45-degree field of view — 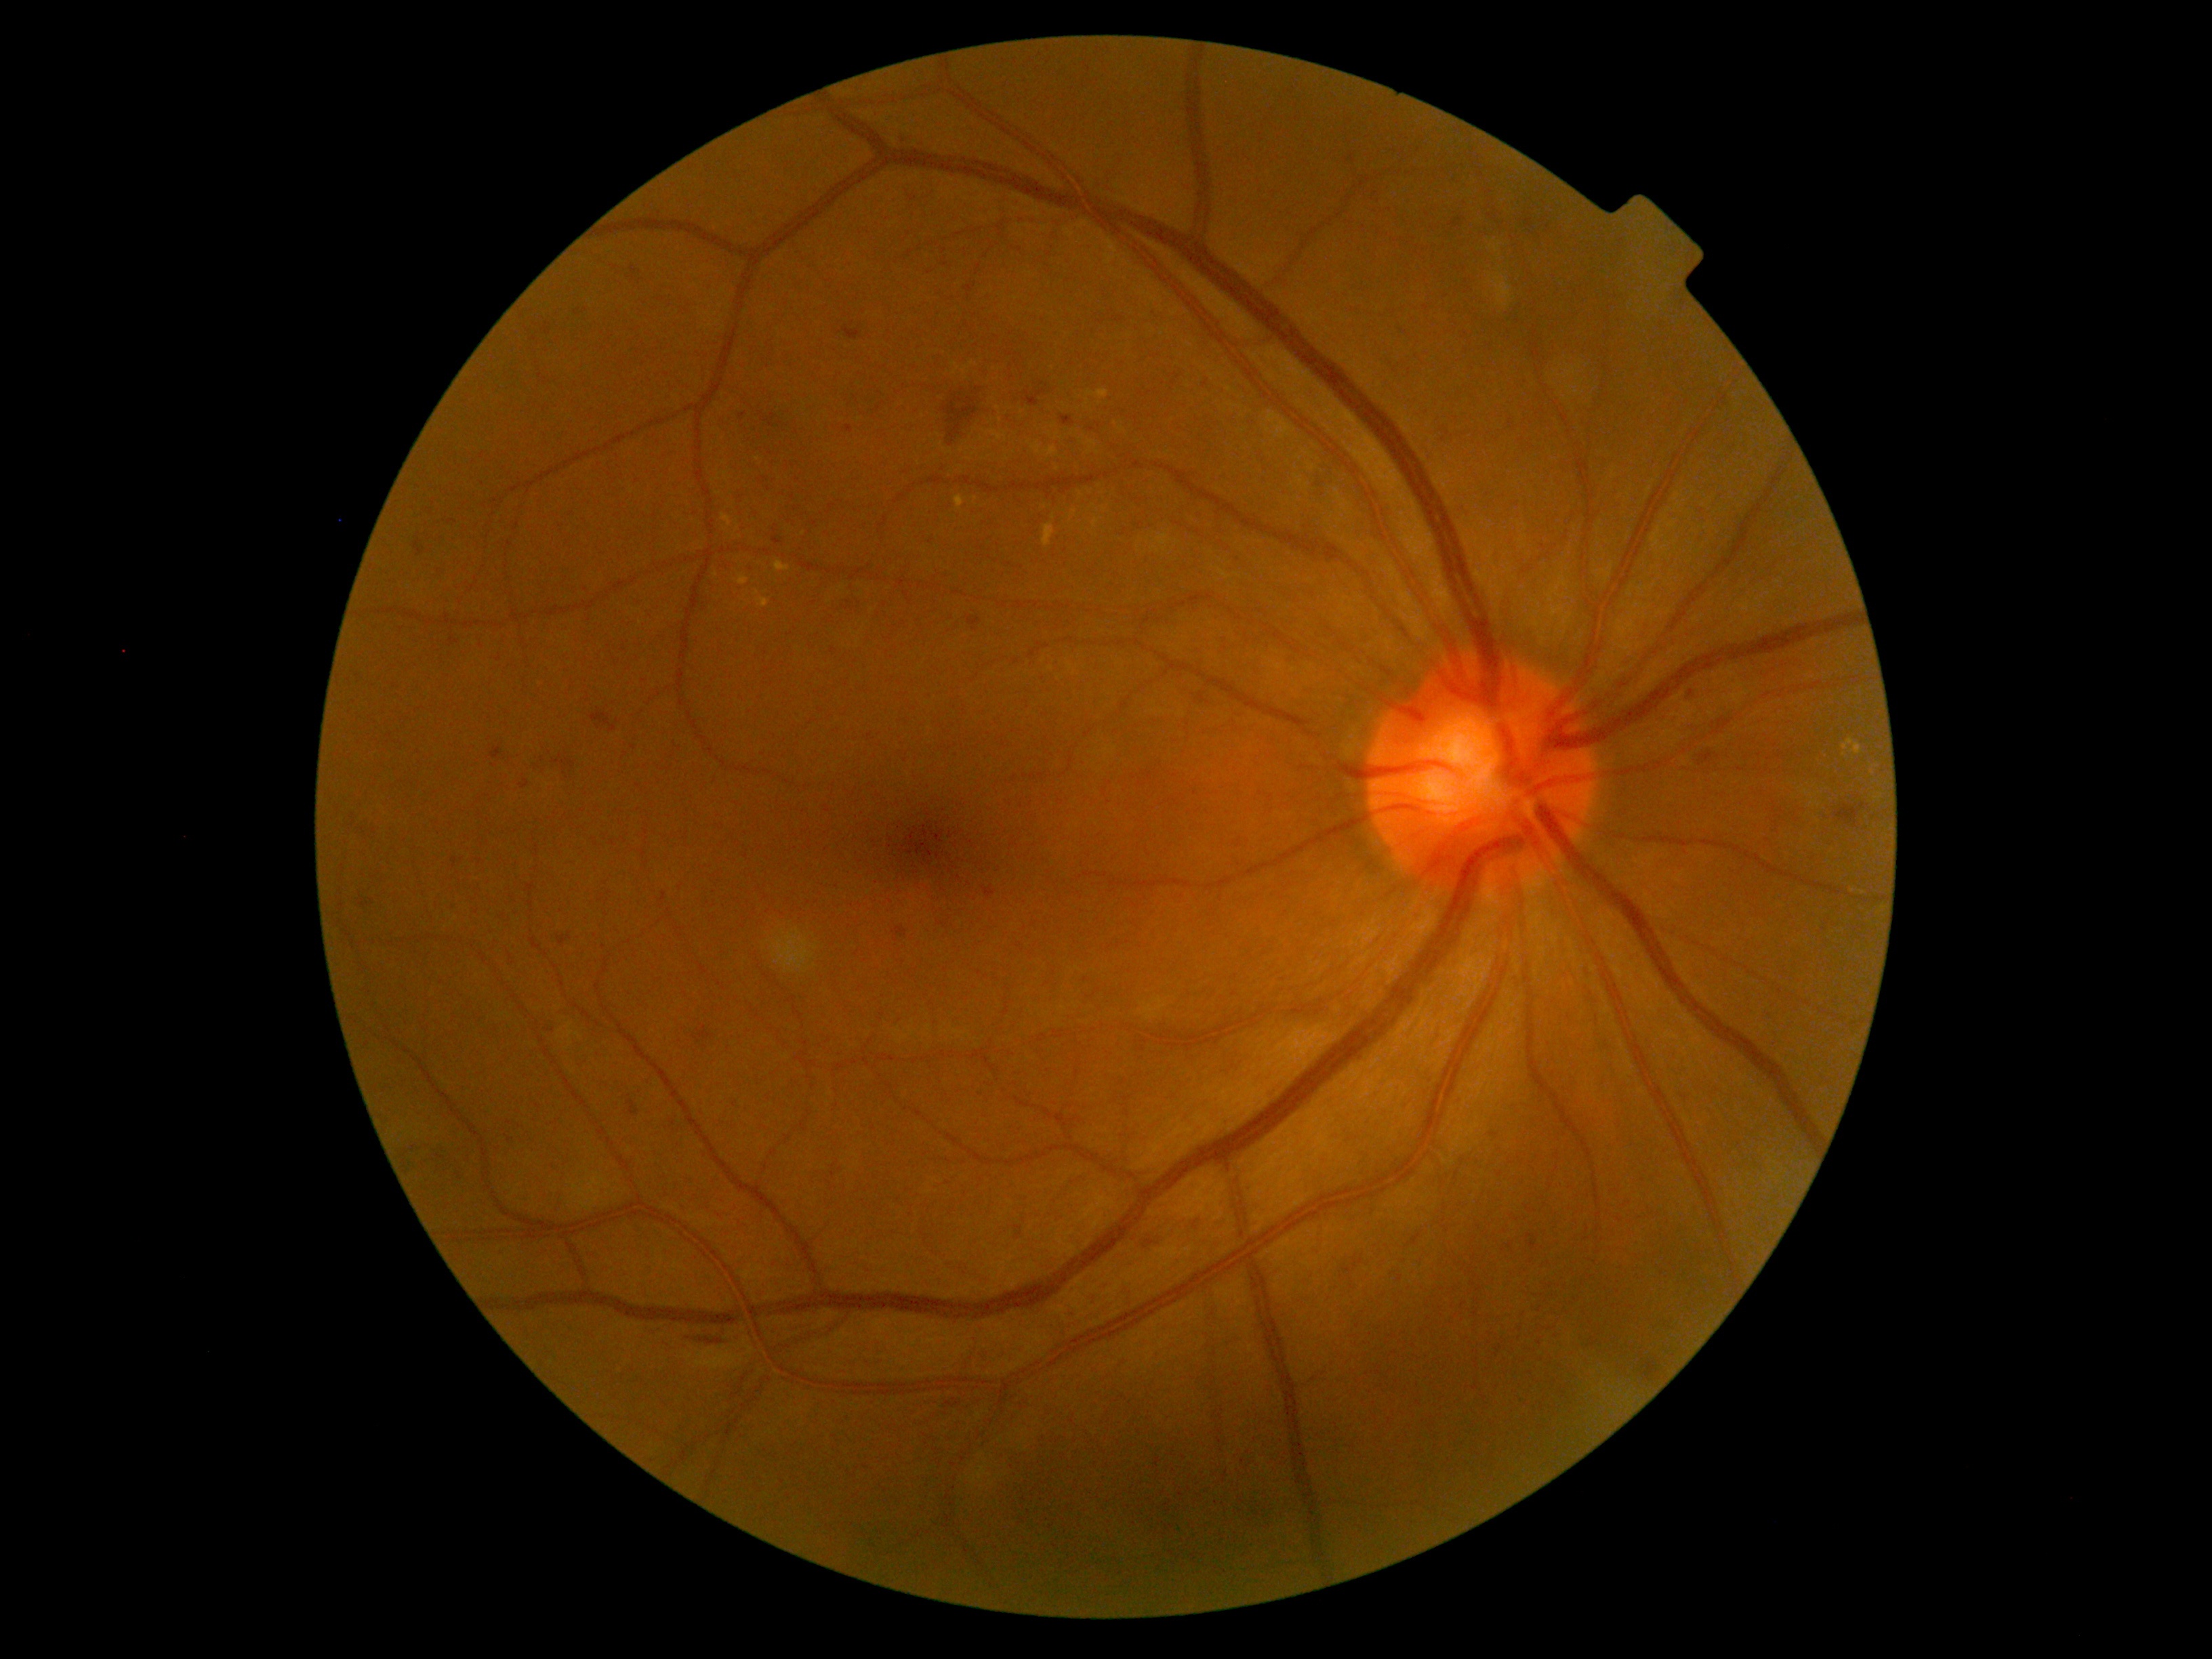

Retinopathy grade: 2 (moderate NPDR)
Representative lesions:
hemorrhages (subset) = [521, 780, 531, 790] | [842, 327, 861, 341] | [547, 1029, 556, 1032] | [1187, 1211, 1203, 1235] | [844, 426, 853, 433] | [1061, 417, 1074, 426] | [413, 541, 424, 556] | [1451, 219, 1465, 230] | [590, 711, 617, 734] | [1197, 692, 1211, 705] | [453, 859, 457, 868] | [773, 537, 783, 546] | [968, 616, 982, 631]
Small hemorrhages near [364, 905] | [1691, 693] | [1091, 430] | [764, 479] | [679, 748]